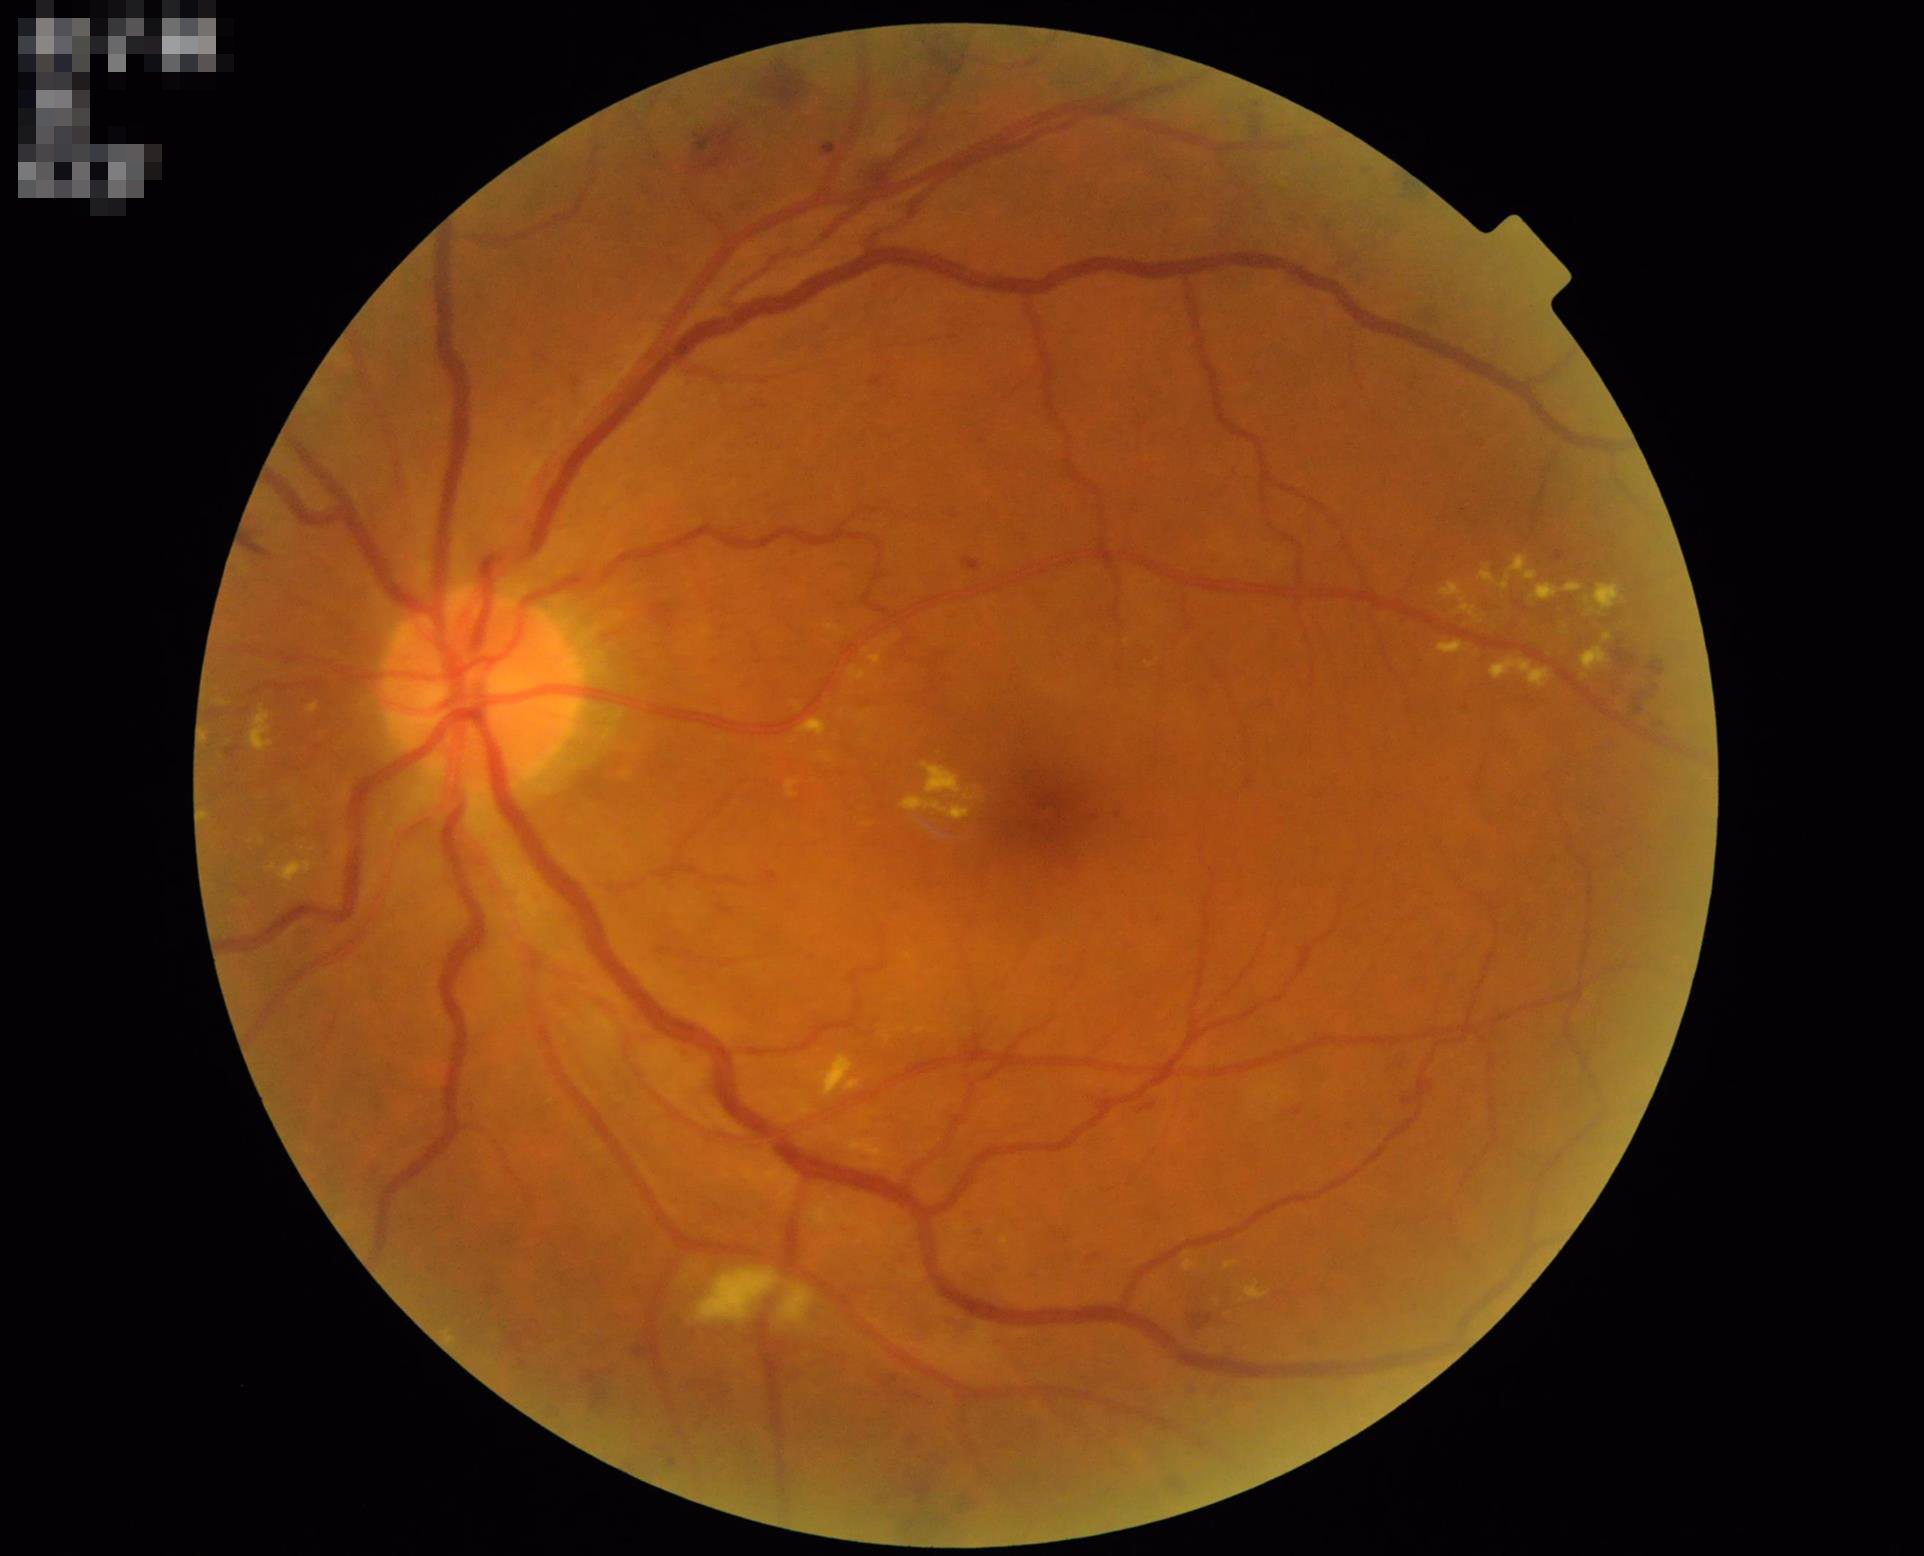 Image quality assessment: contrast: satisfactory | illumination: satisfactory | sharpness: clear | overall: adequate.